640x480px; pediatric retinal photograph (wide-field).
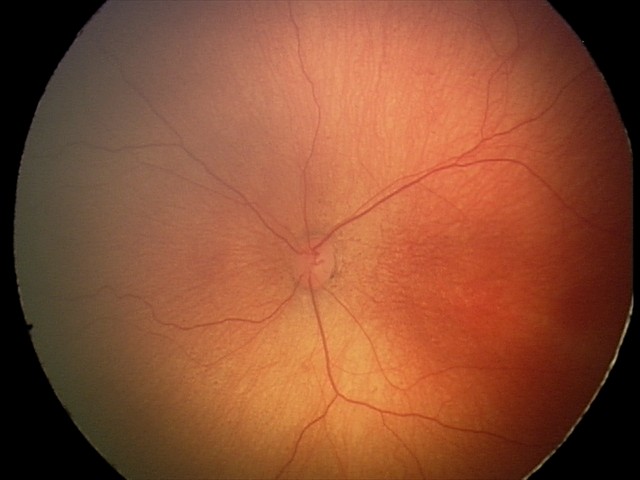

Assessment: ROP stage 1.